CFP · image size 512x512: 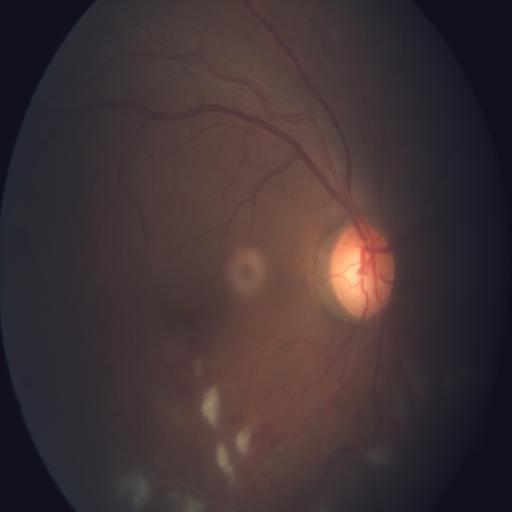
Diagnoses:
- cotton wool spots (CWS)
- media haze (MH)